Diabetic retinopathy graded by the modified Davis classification · without pupil dilation: 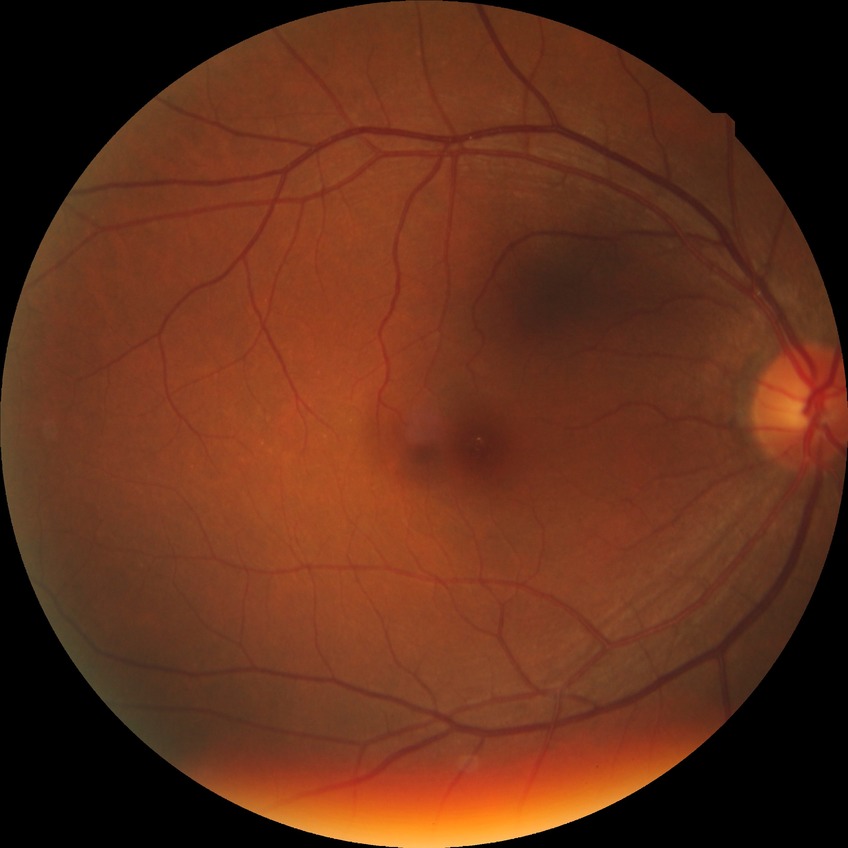 Findings:
* retinopathy stage: no diabetic retinopathy